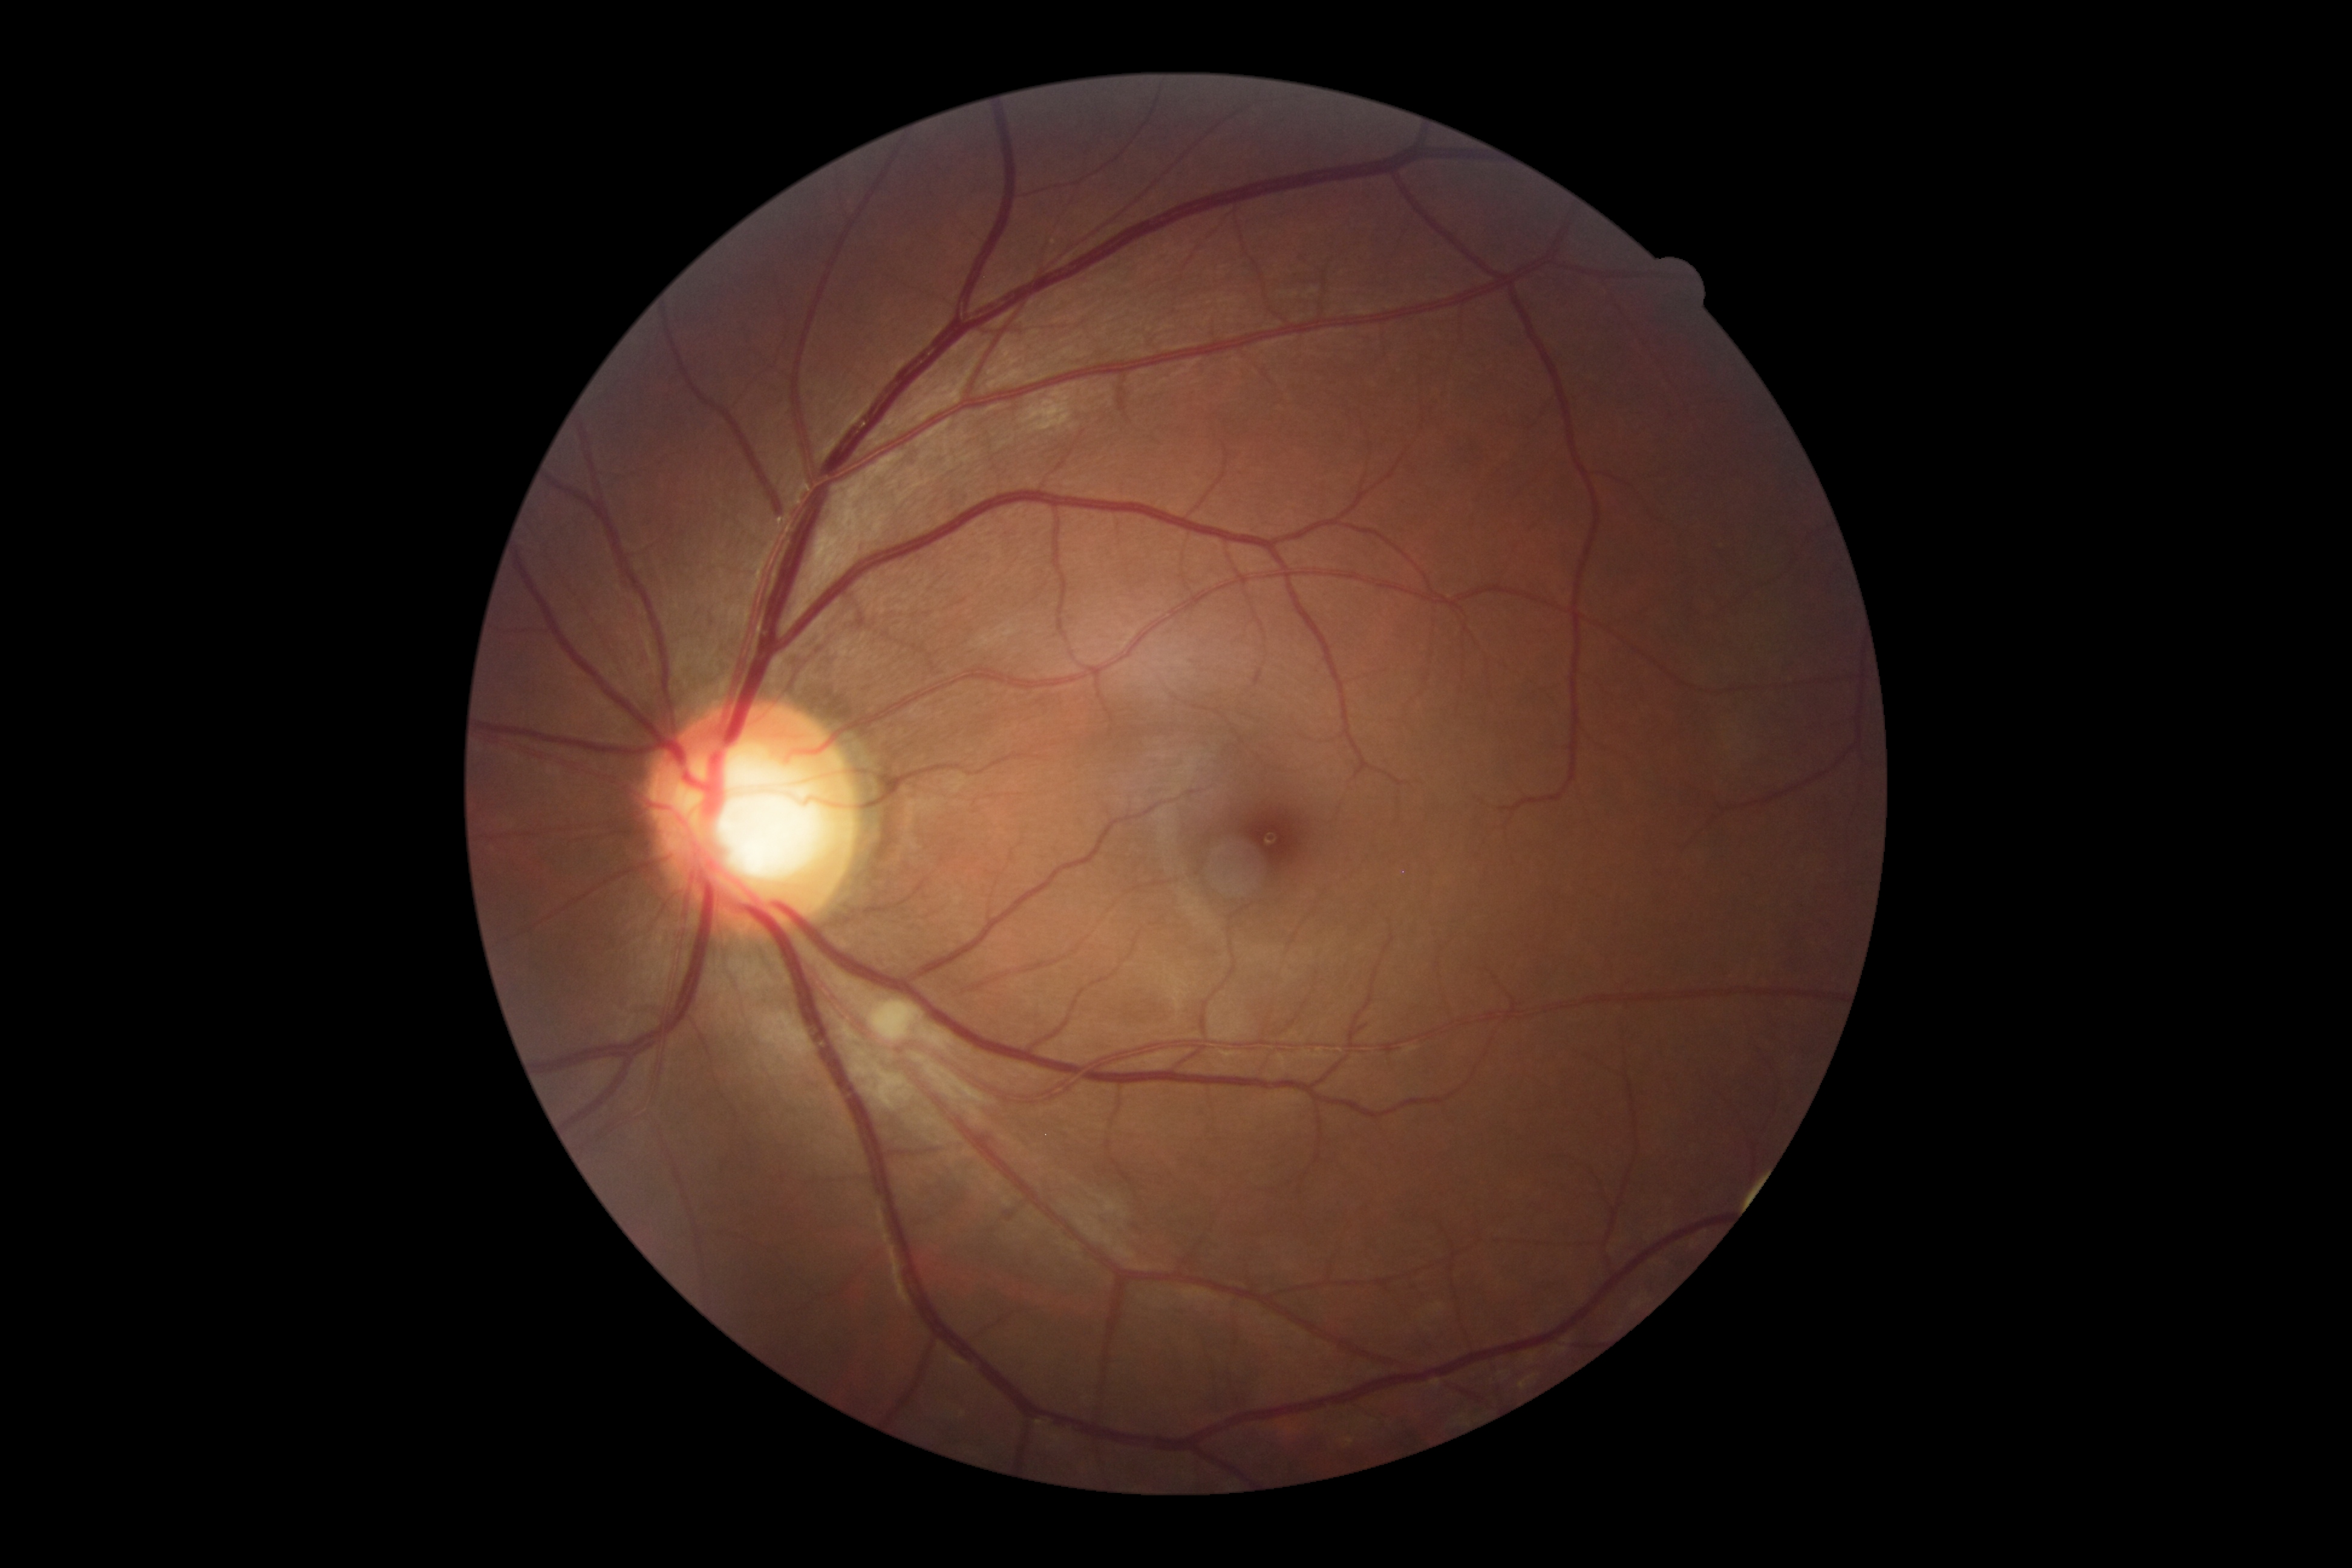

DR severity: grade 2.